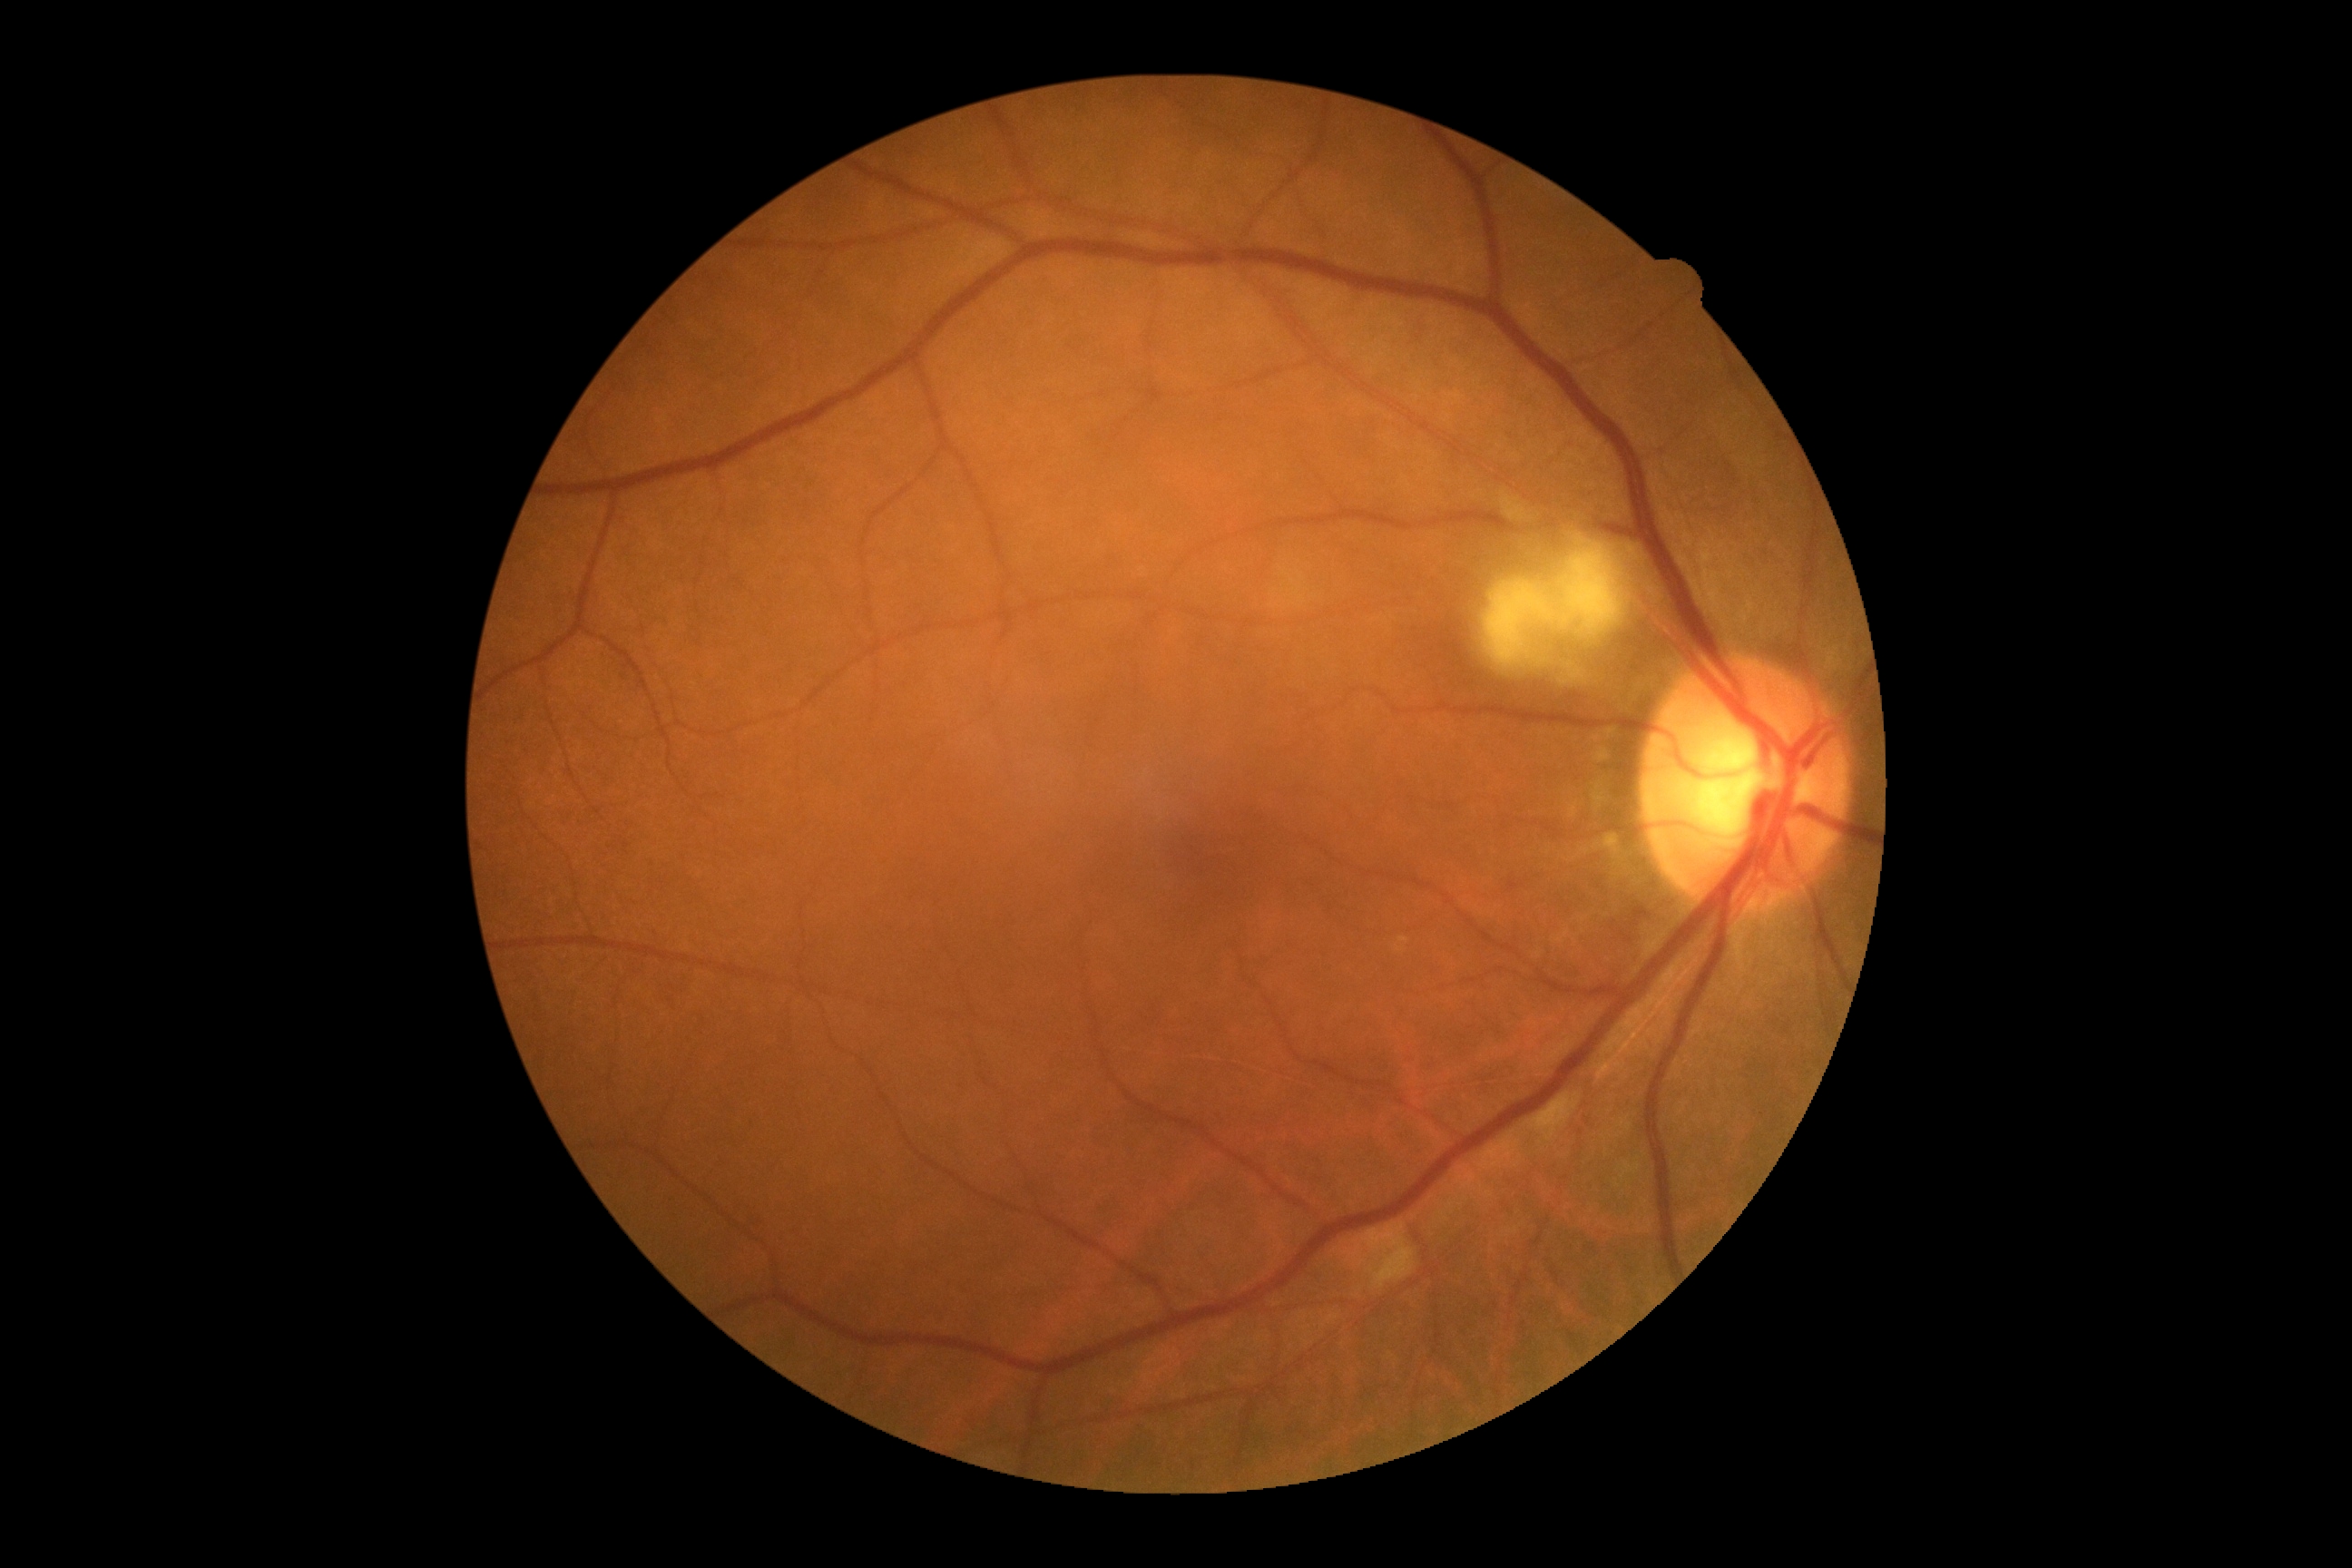

Retinopathy is grade 2 (moderate NPDR).